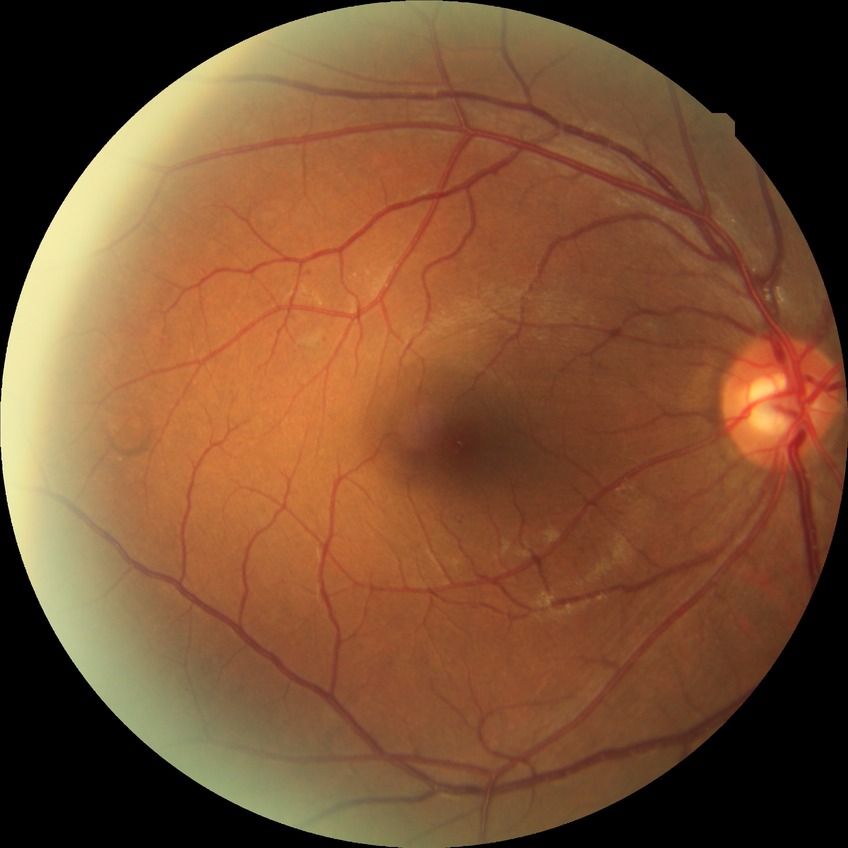
diabetic retinopathy grade@simple diabetic retinopathy.